Acquired with a Topcon TRC-50DX, field includes the optic disc and macula, fundus photo, pupil-dilated, 2228 x 1652 pixels — 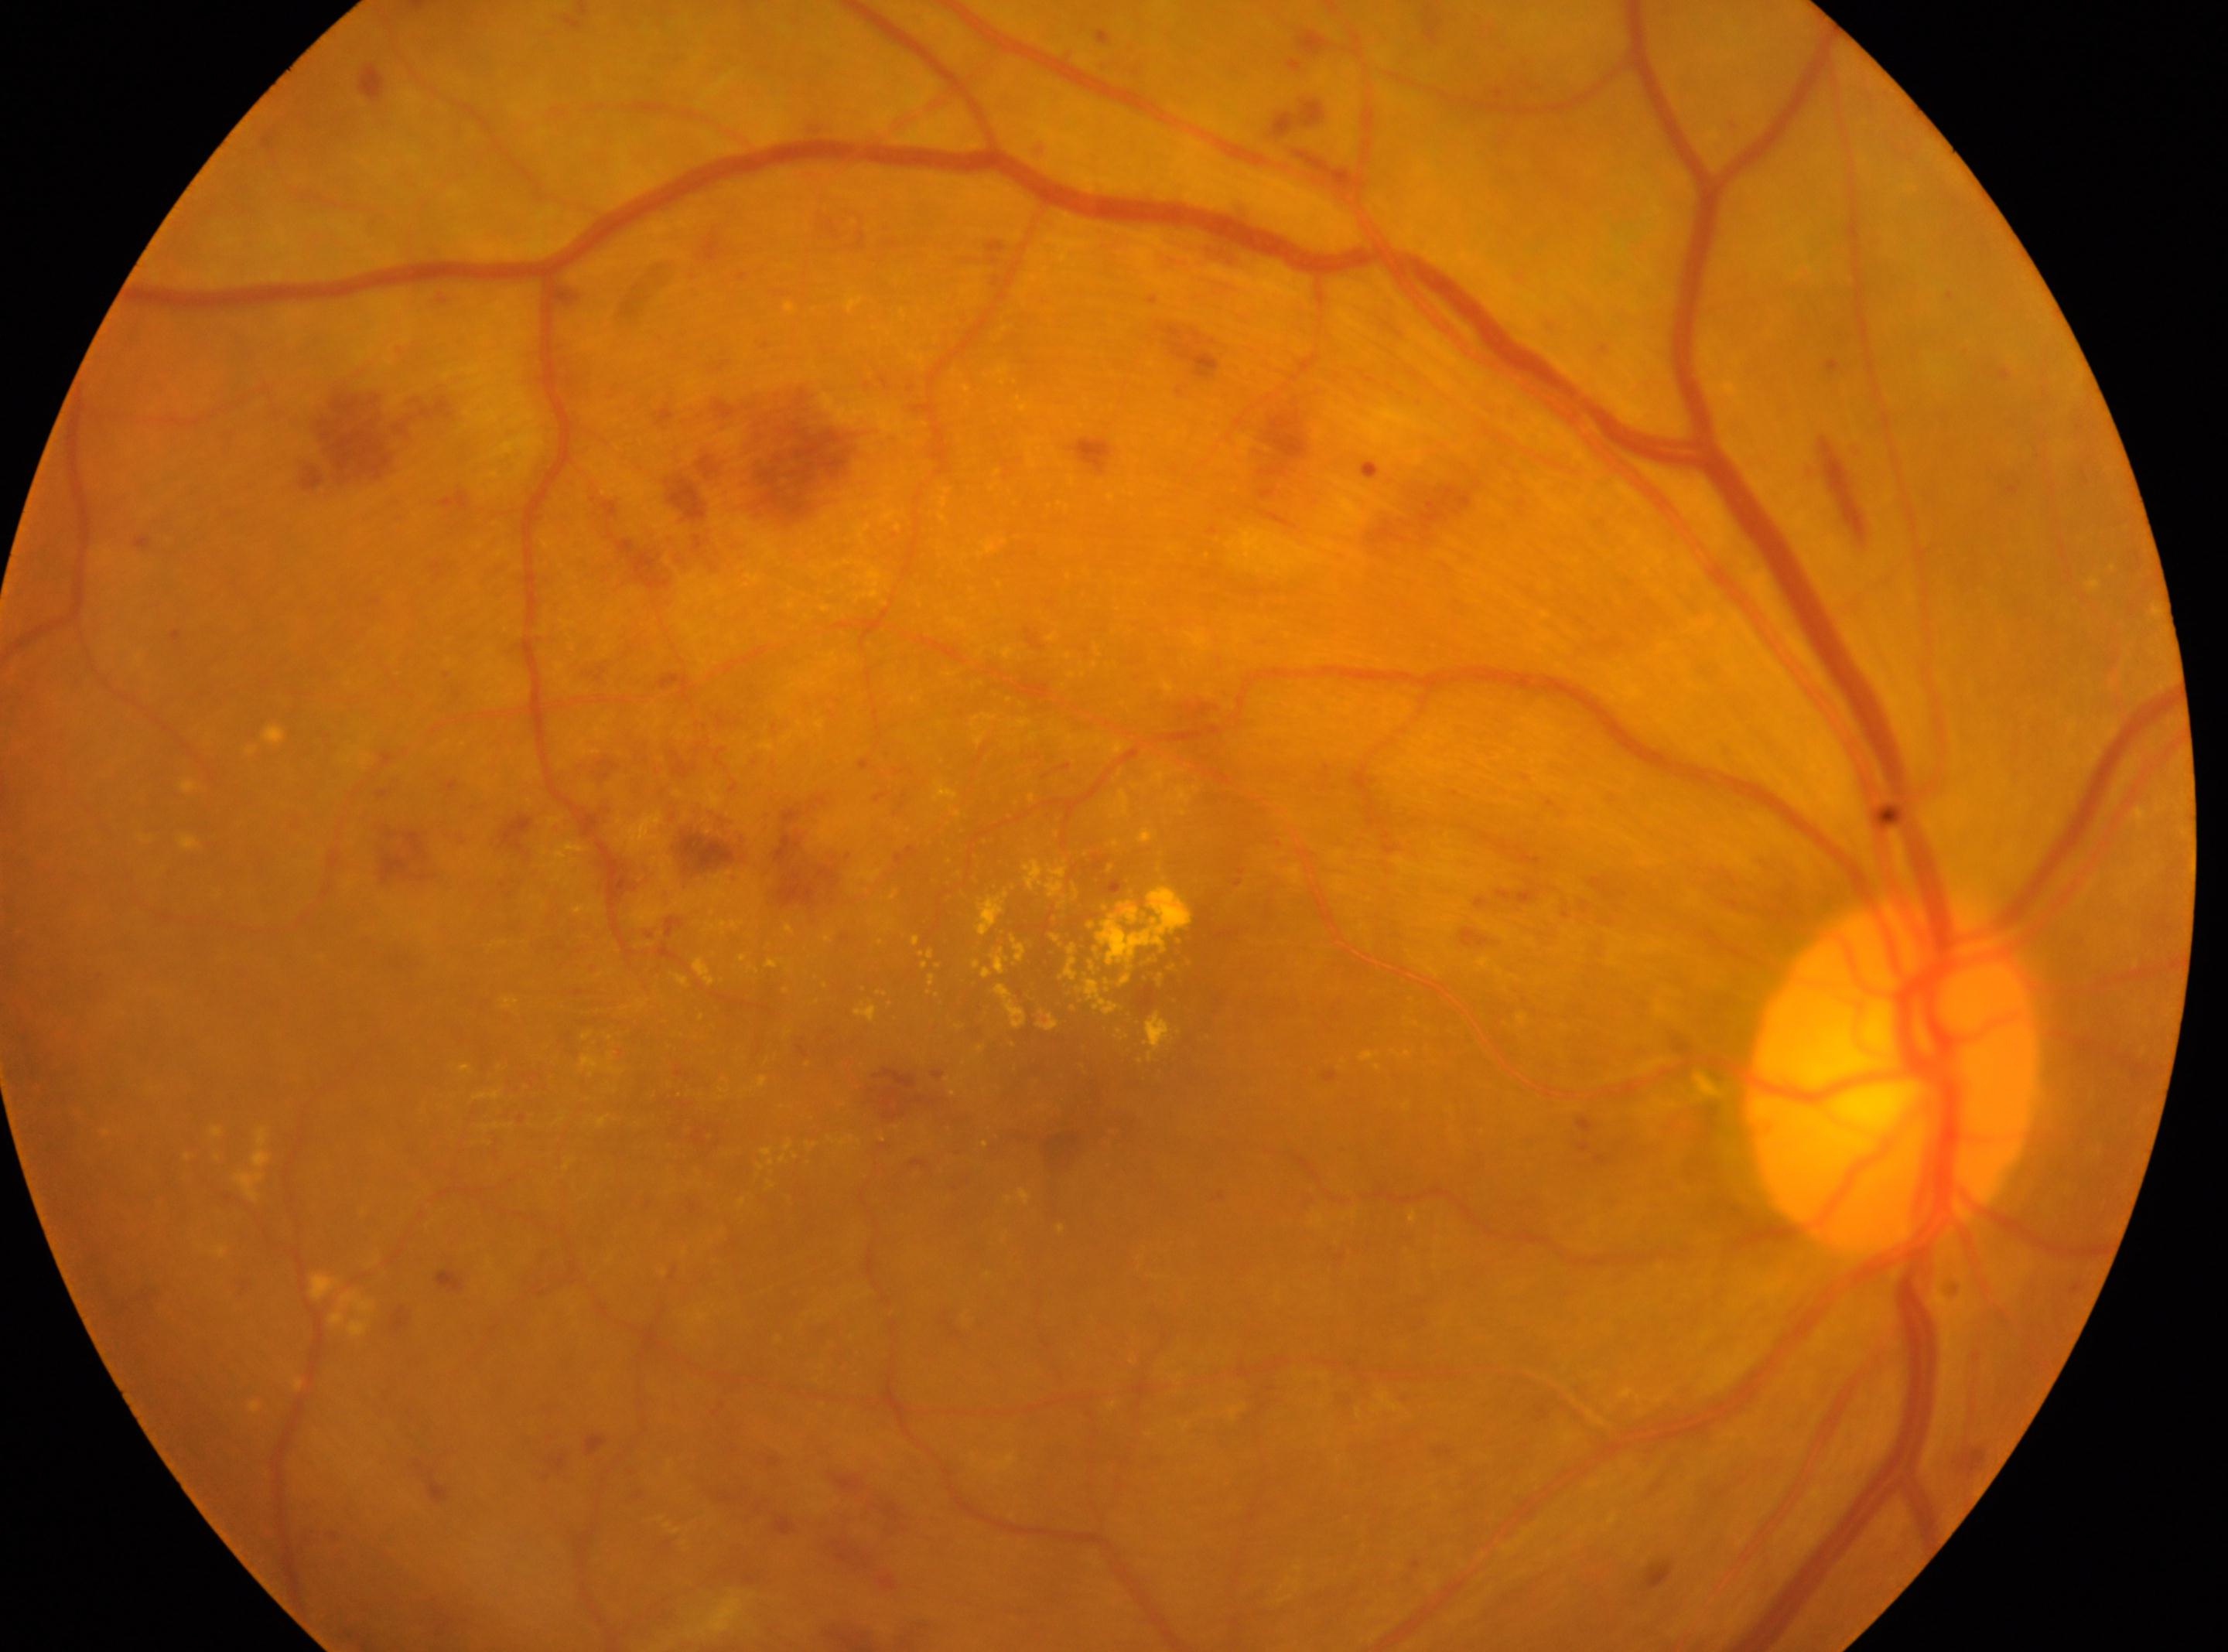 Fovea centralis located at x=1063, y=1078. Disc center: x=1895, y=1080. The image shows the OD. Diabetic retinopathy (DR) is grade 3.